Modified Davis grading, nonmydriatic: 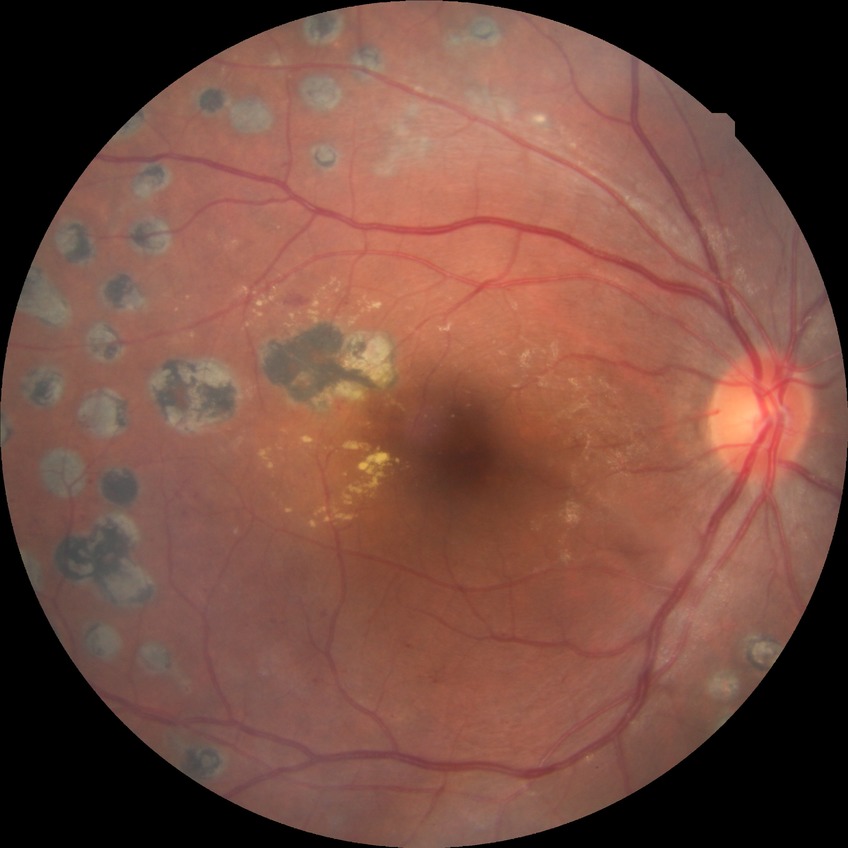

Diabetic retinopathy (DR) is proliferative diabetic retinopathy (PDR).